FOV: 45 degrees — 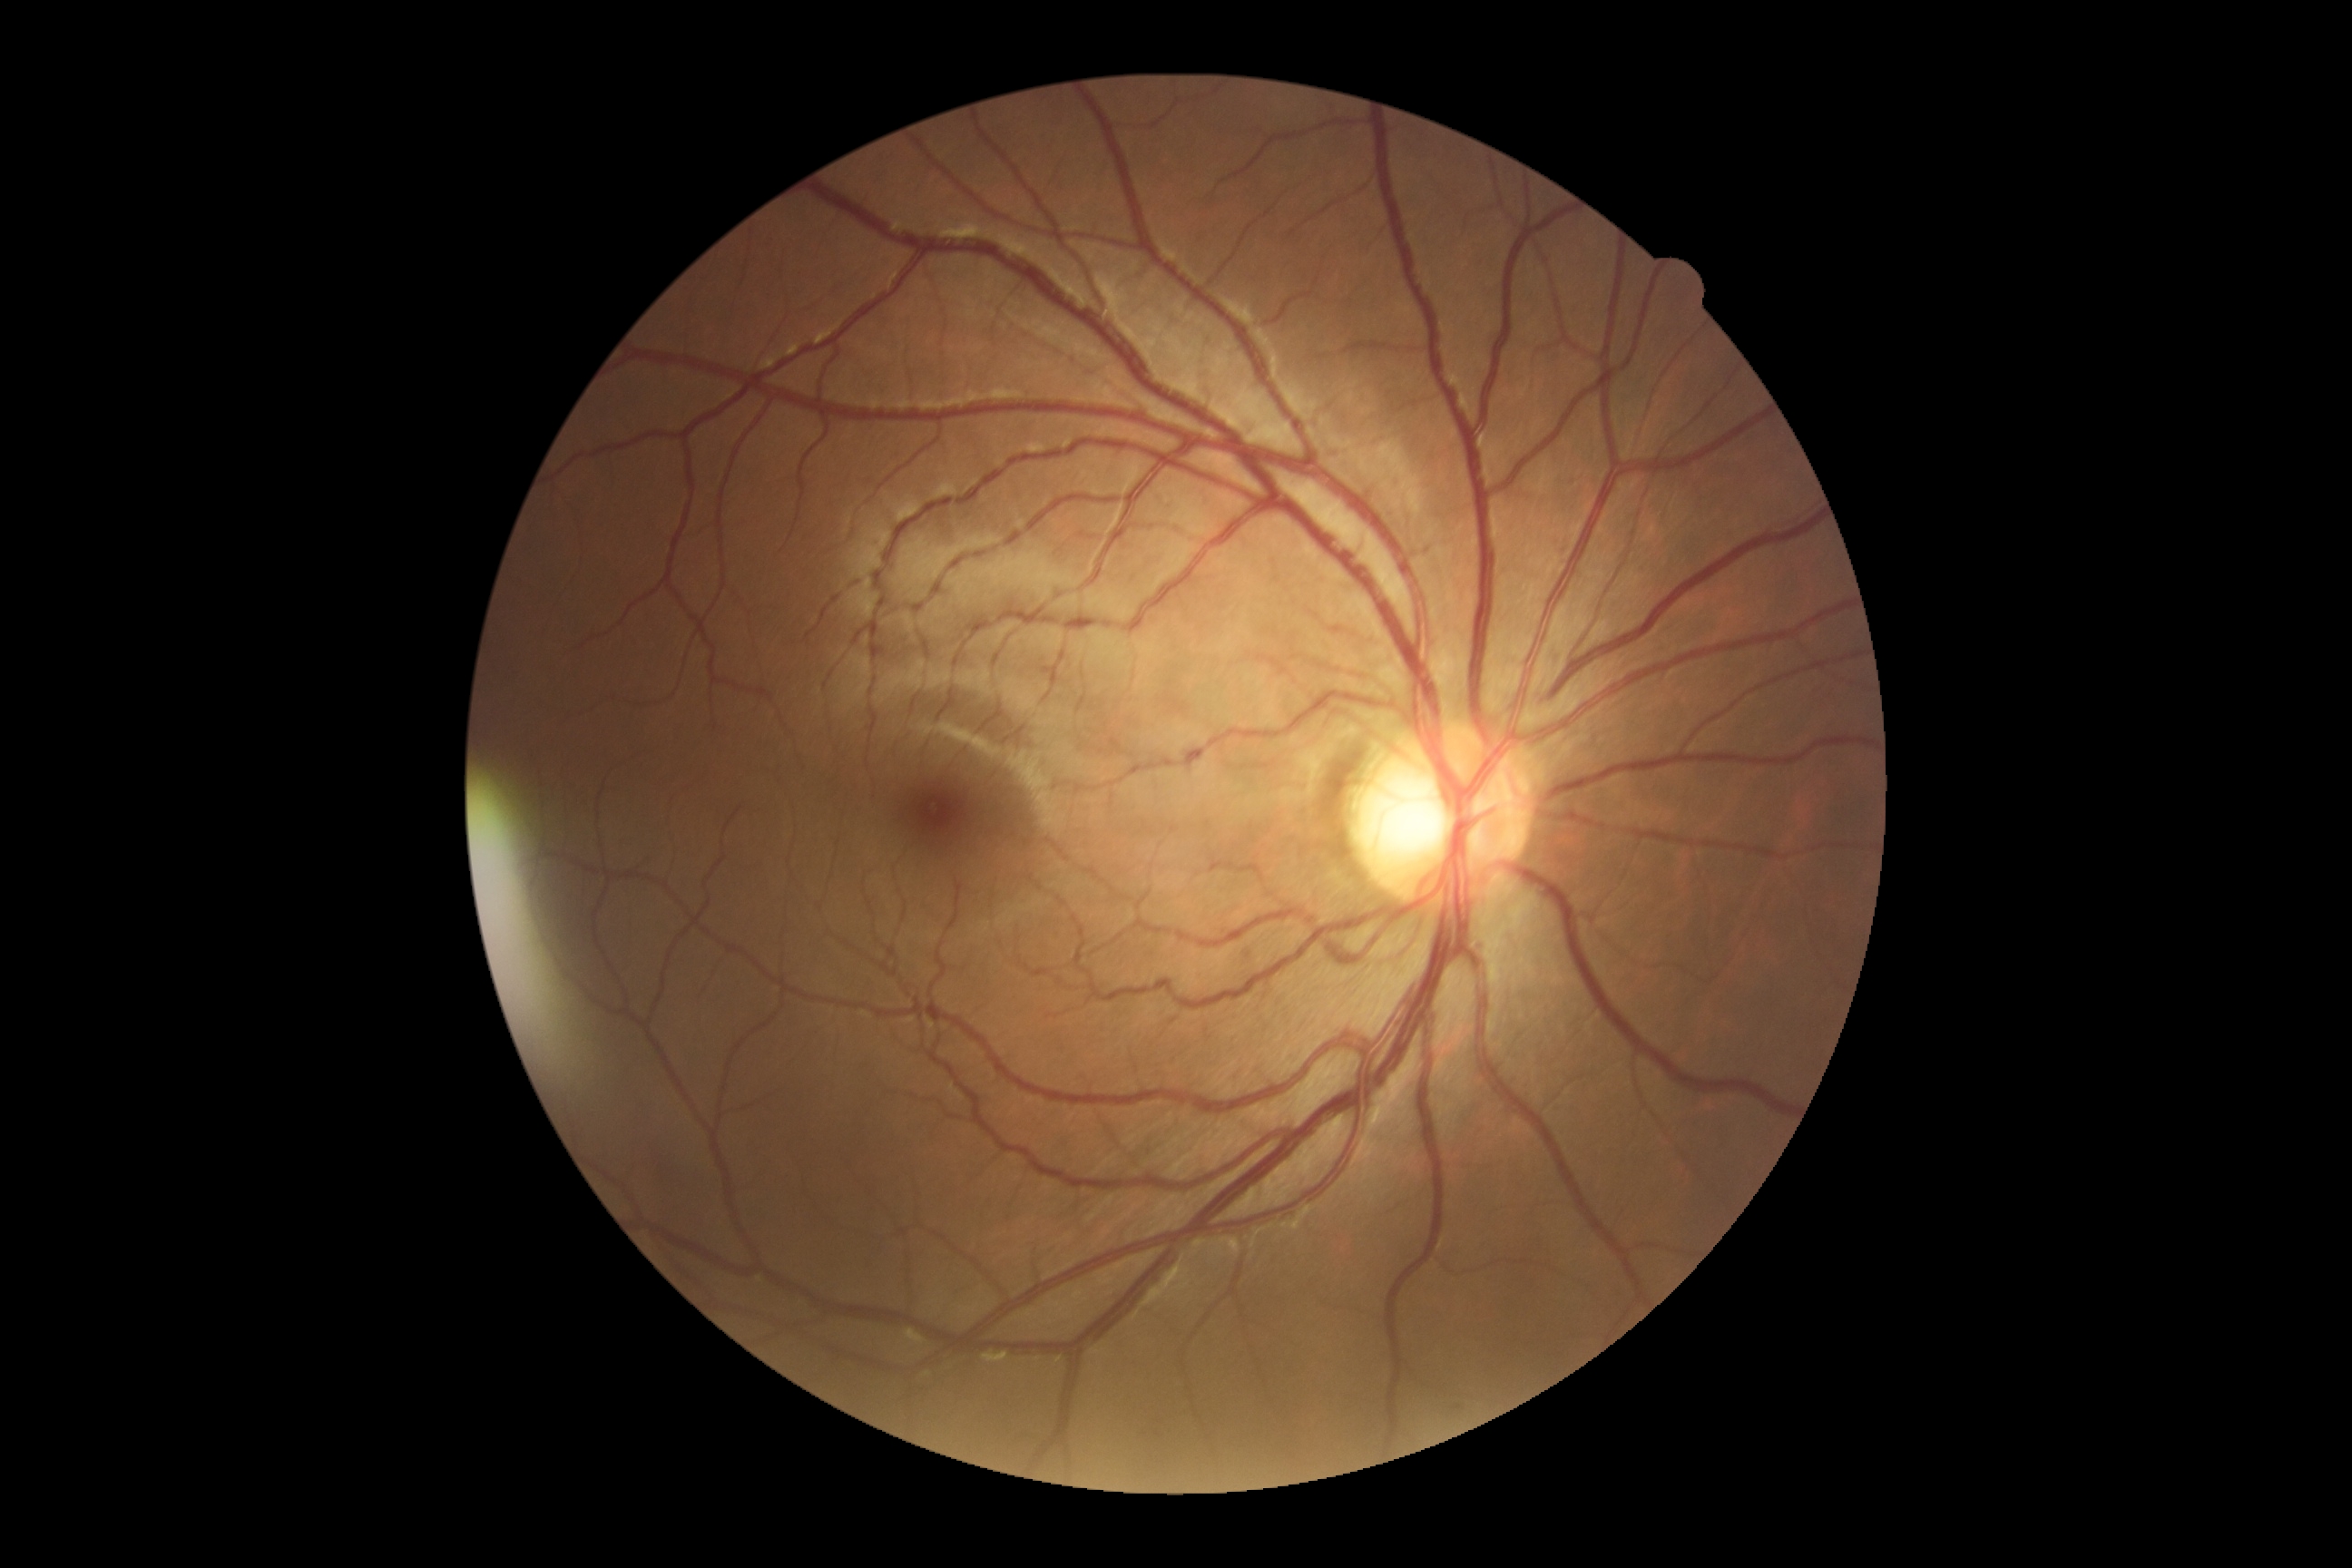 Diabetic retinopathy (DR) is grade 0. No DR findings.